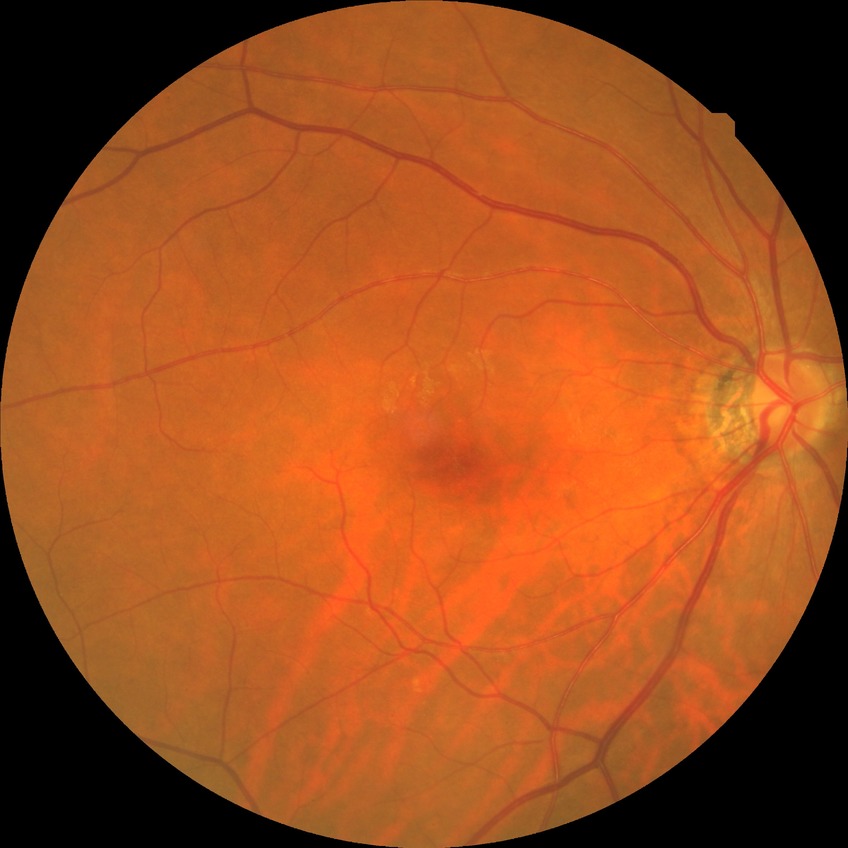
Davis stage: NDR.